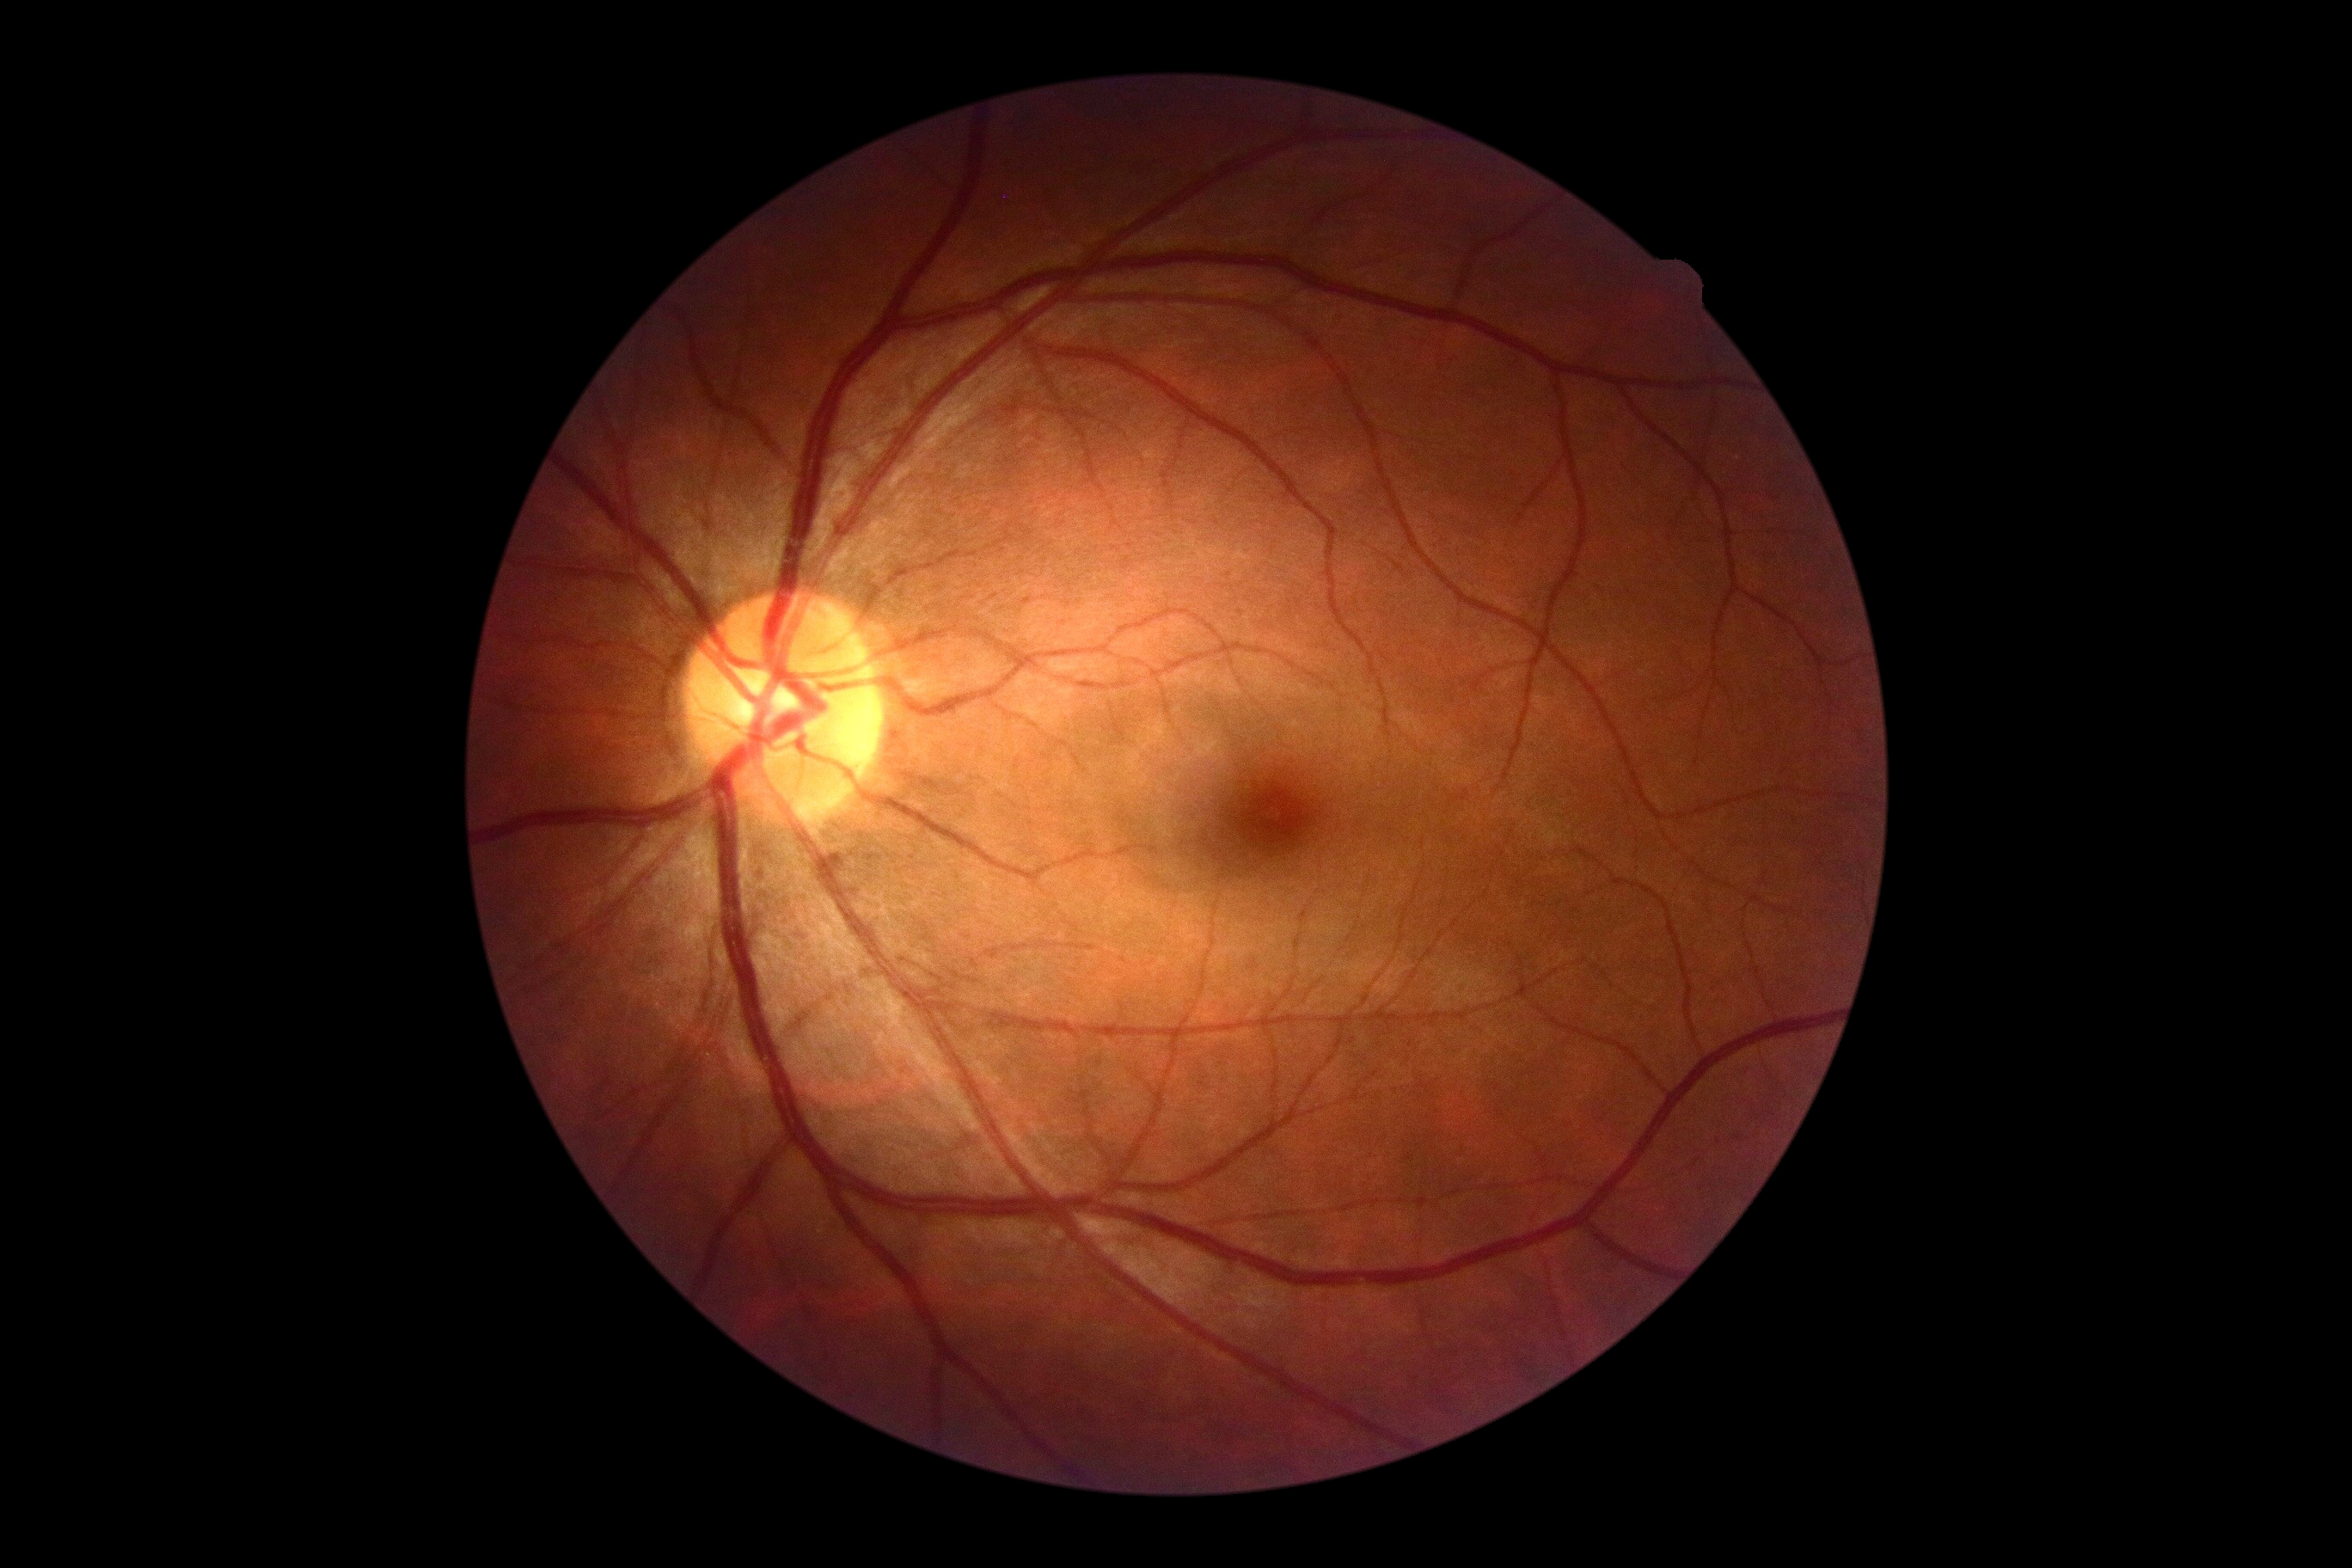 Retinopathy: grade 0 (no apparent retinopathy).